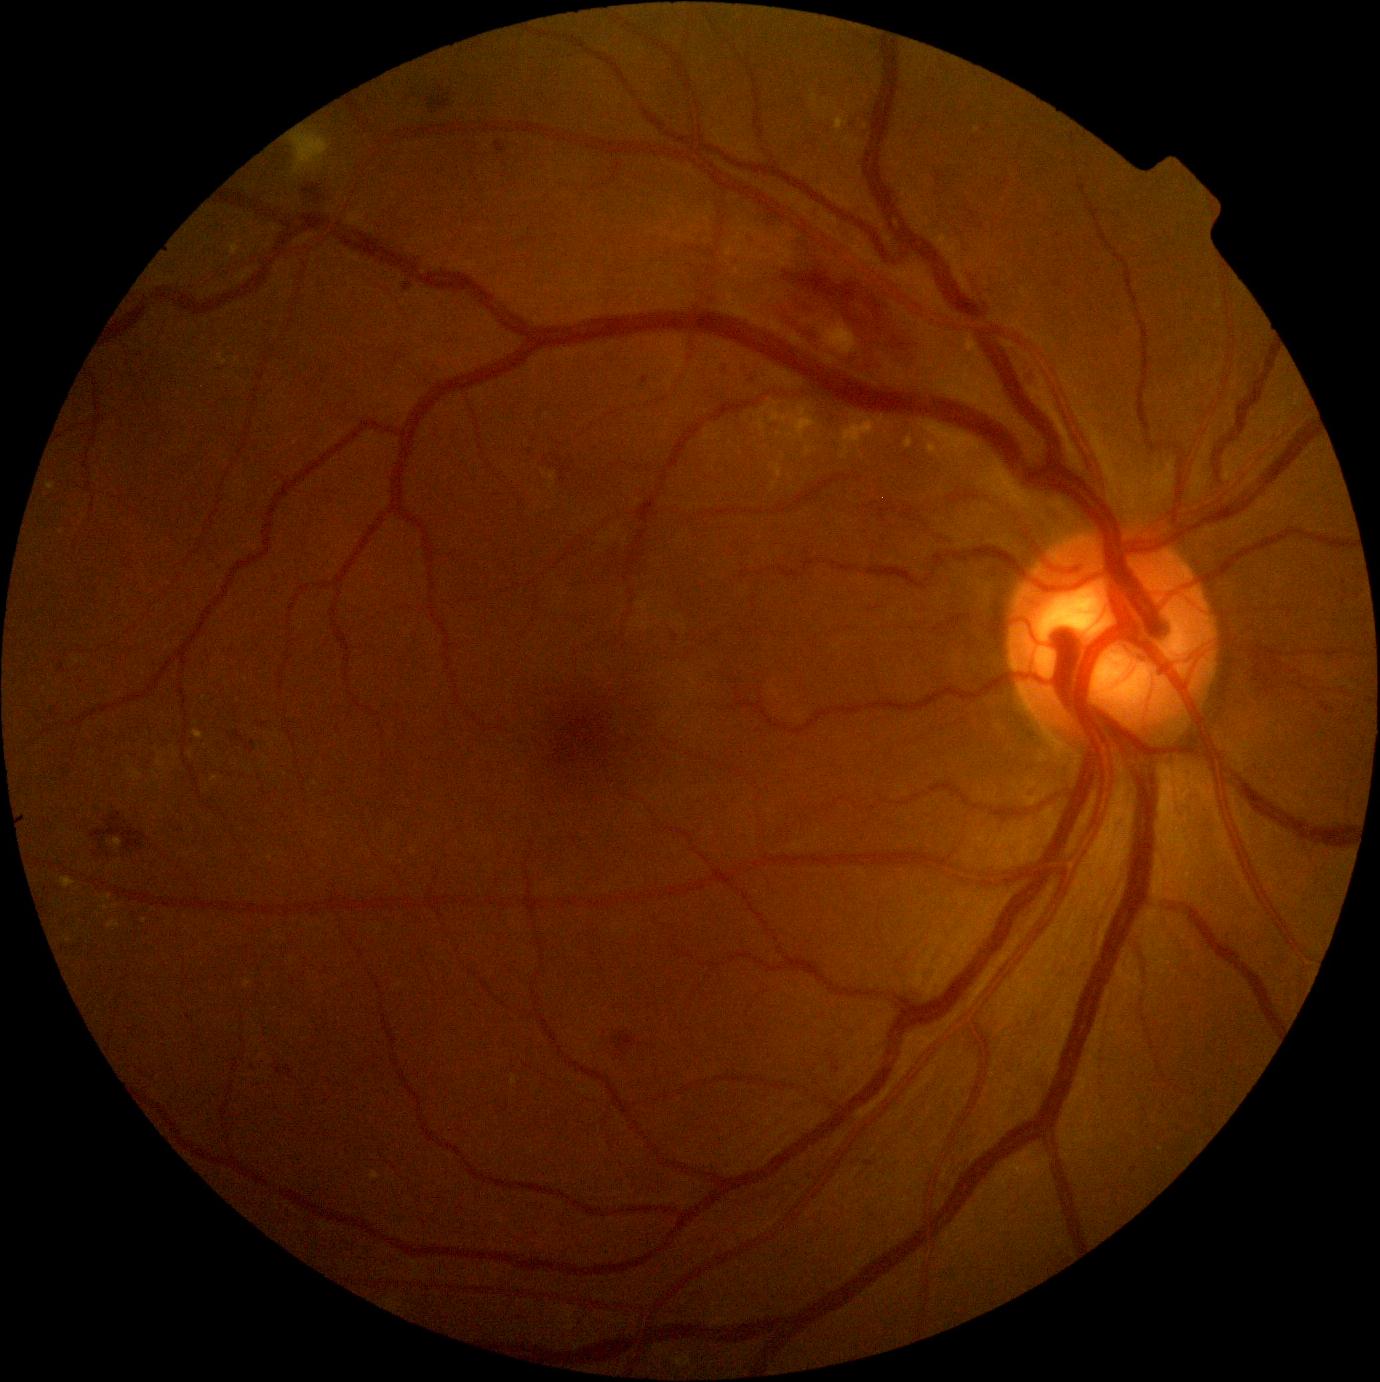 Diabetic retinopathy (DR): grade 2.